Wide-field fundus photograph from neonatal ROP screening; captured with the Phoenix ICON (100° field of view)
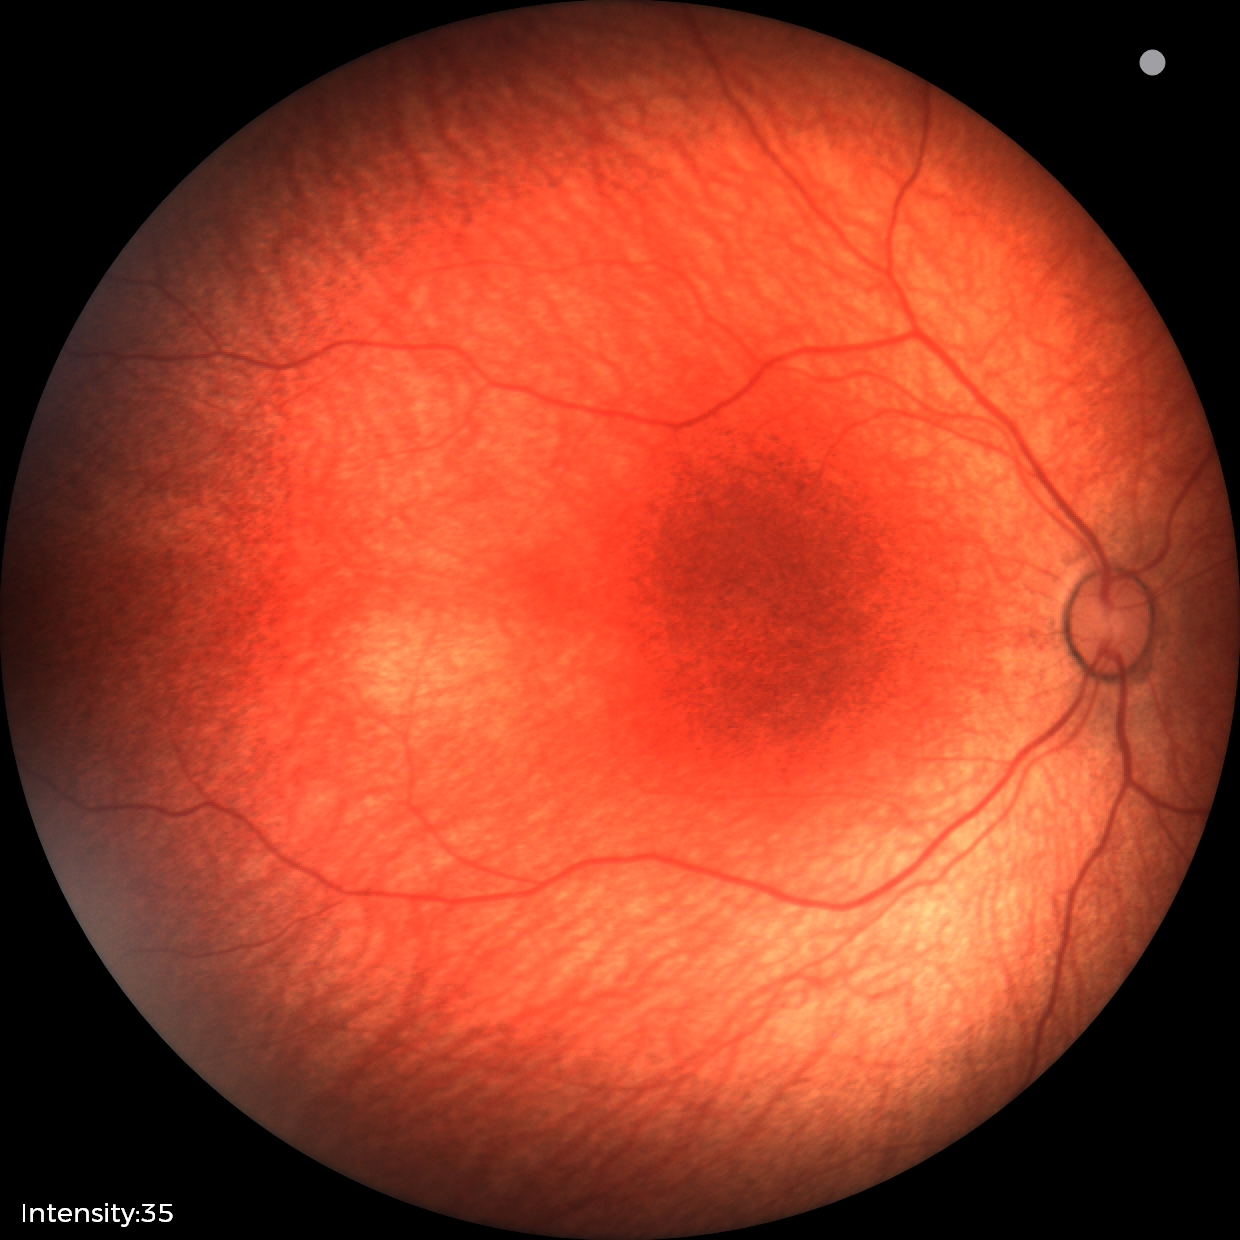 Screening examination with no abnormal retinal findings.